Posterior pole field covering the optic disc and macula: 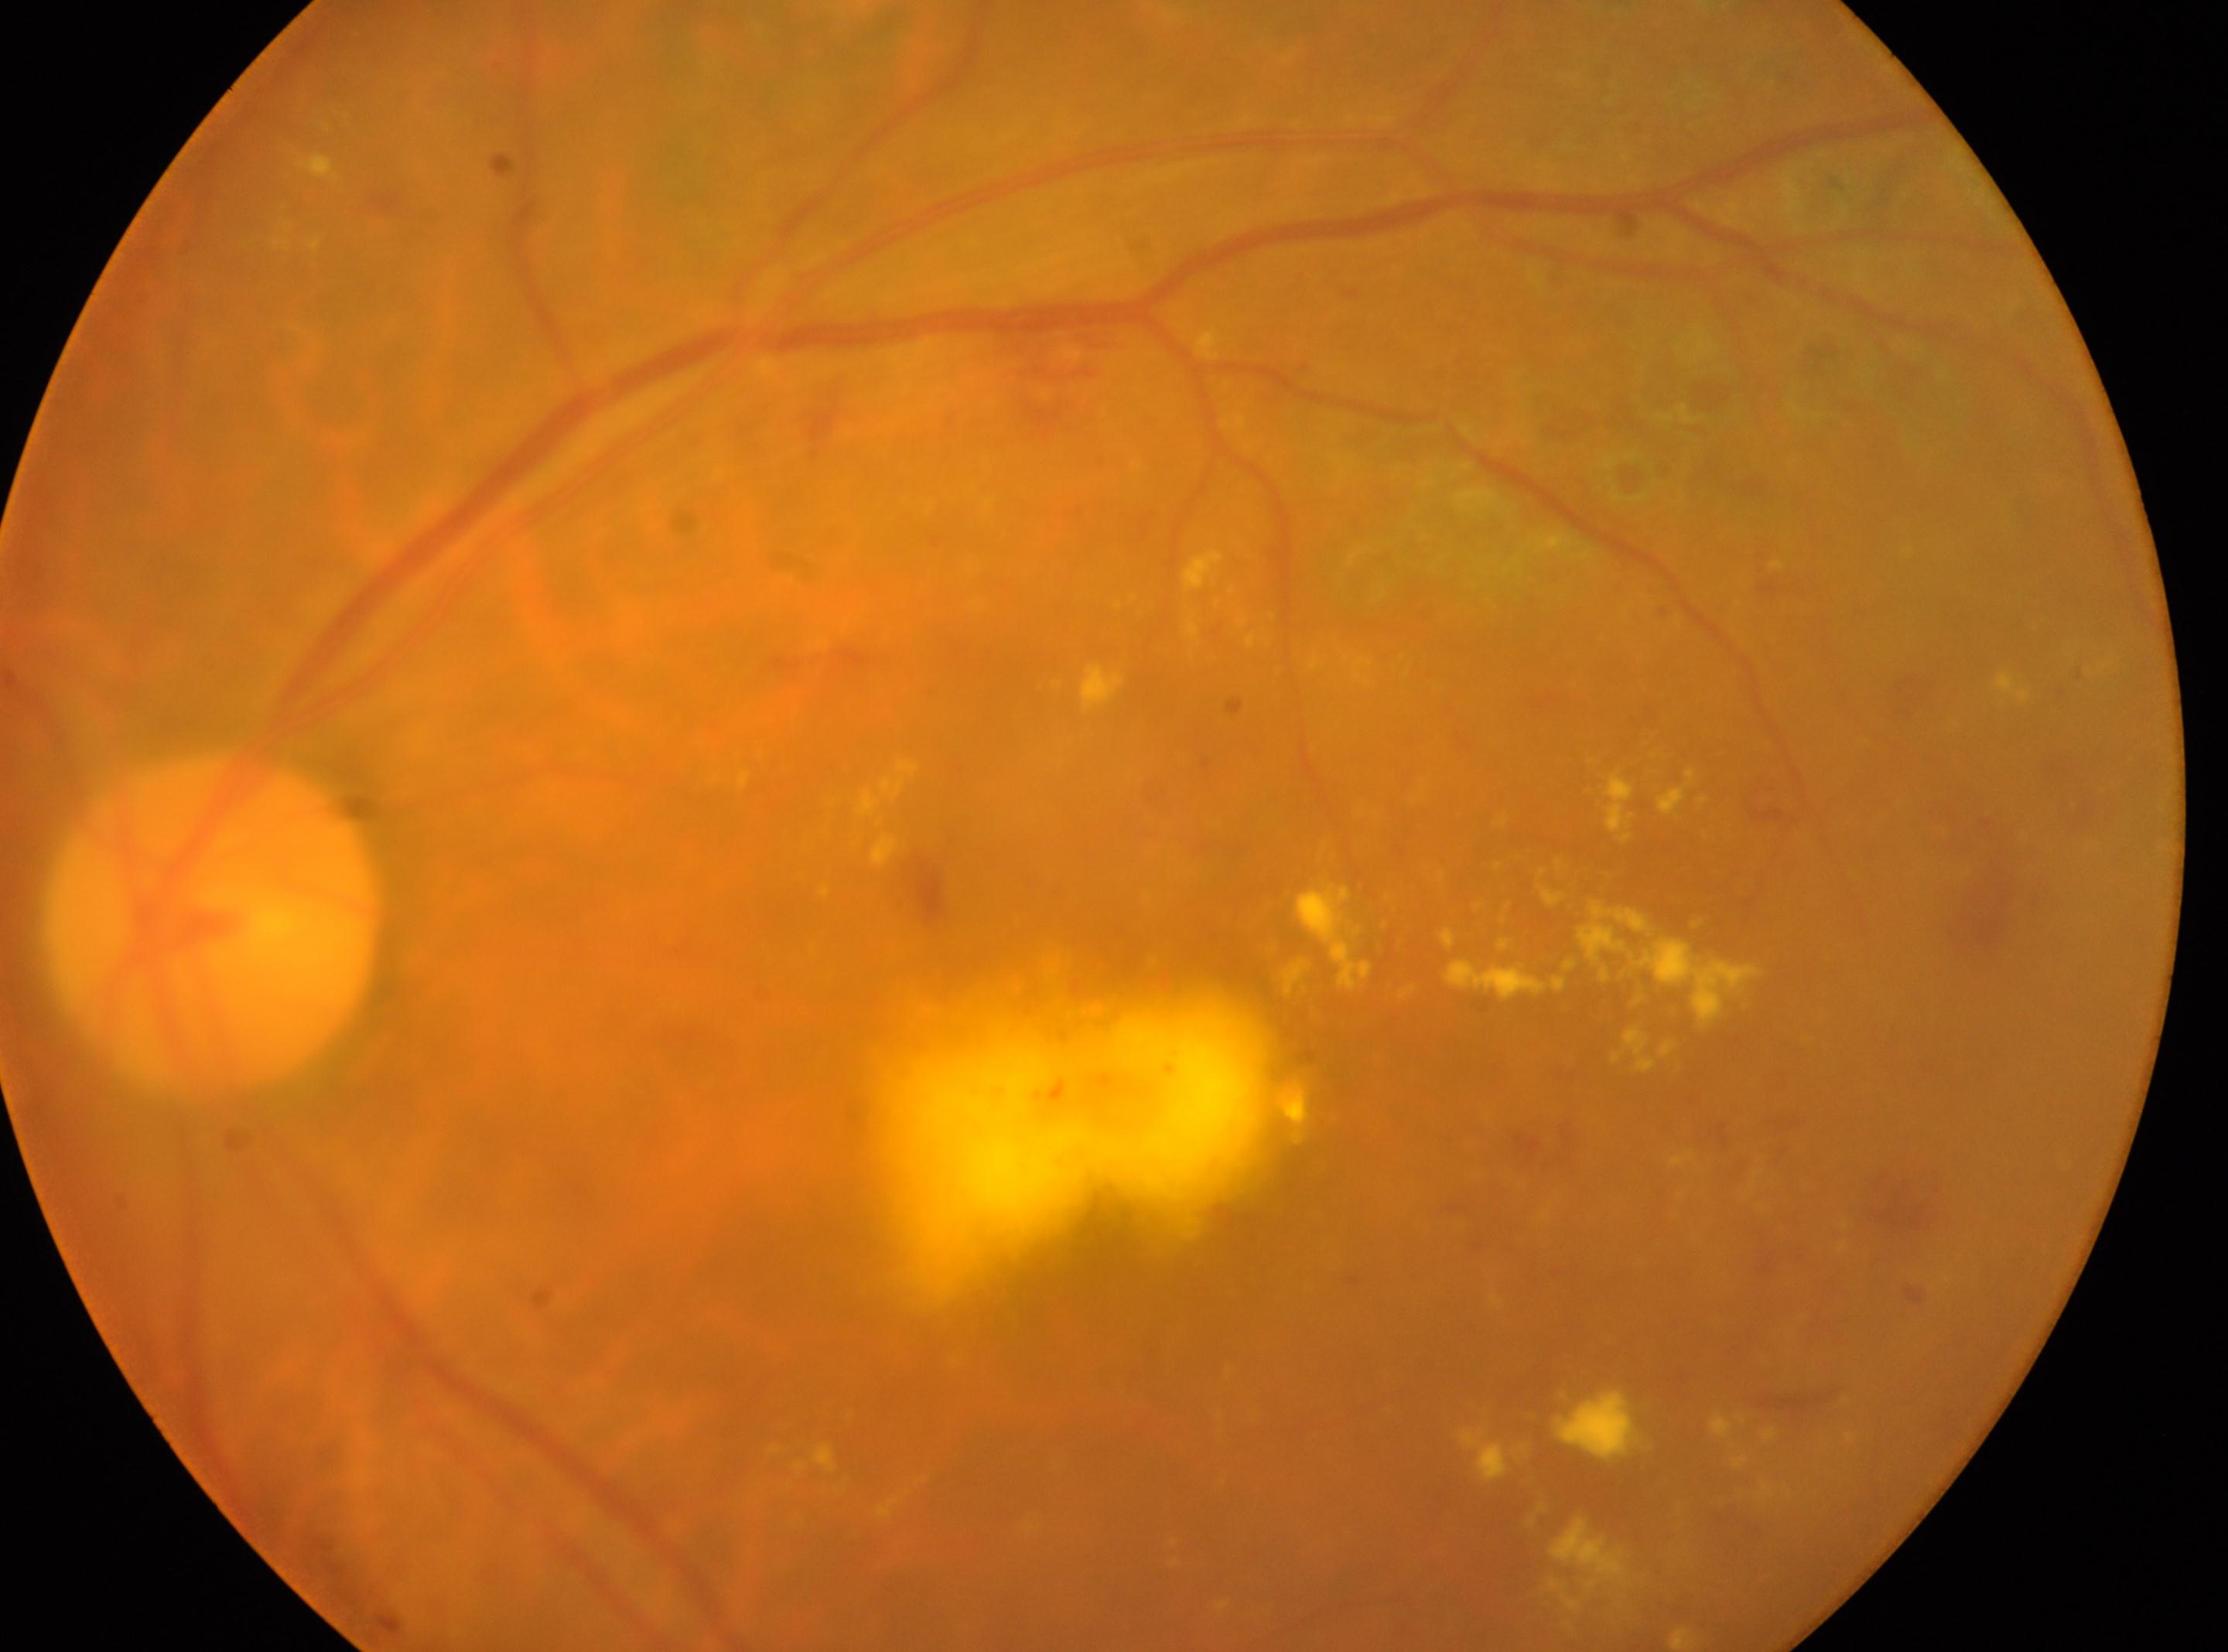 • laterality — the left eye
• disc center — 212px, 927px
• retinopathy — DR with laser photocoagulation scars
• the fovea — 1072px, 1056px